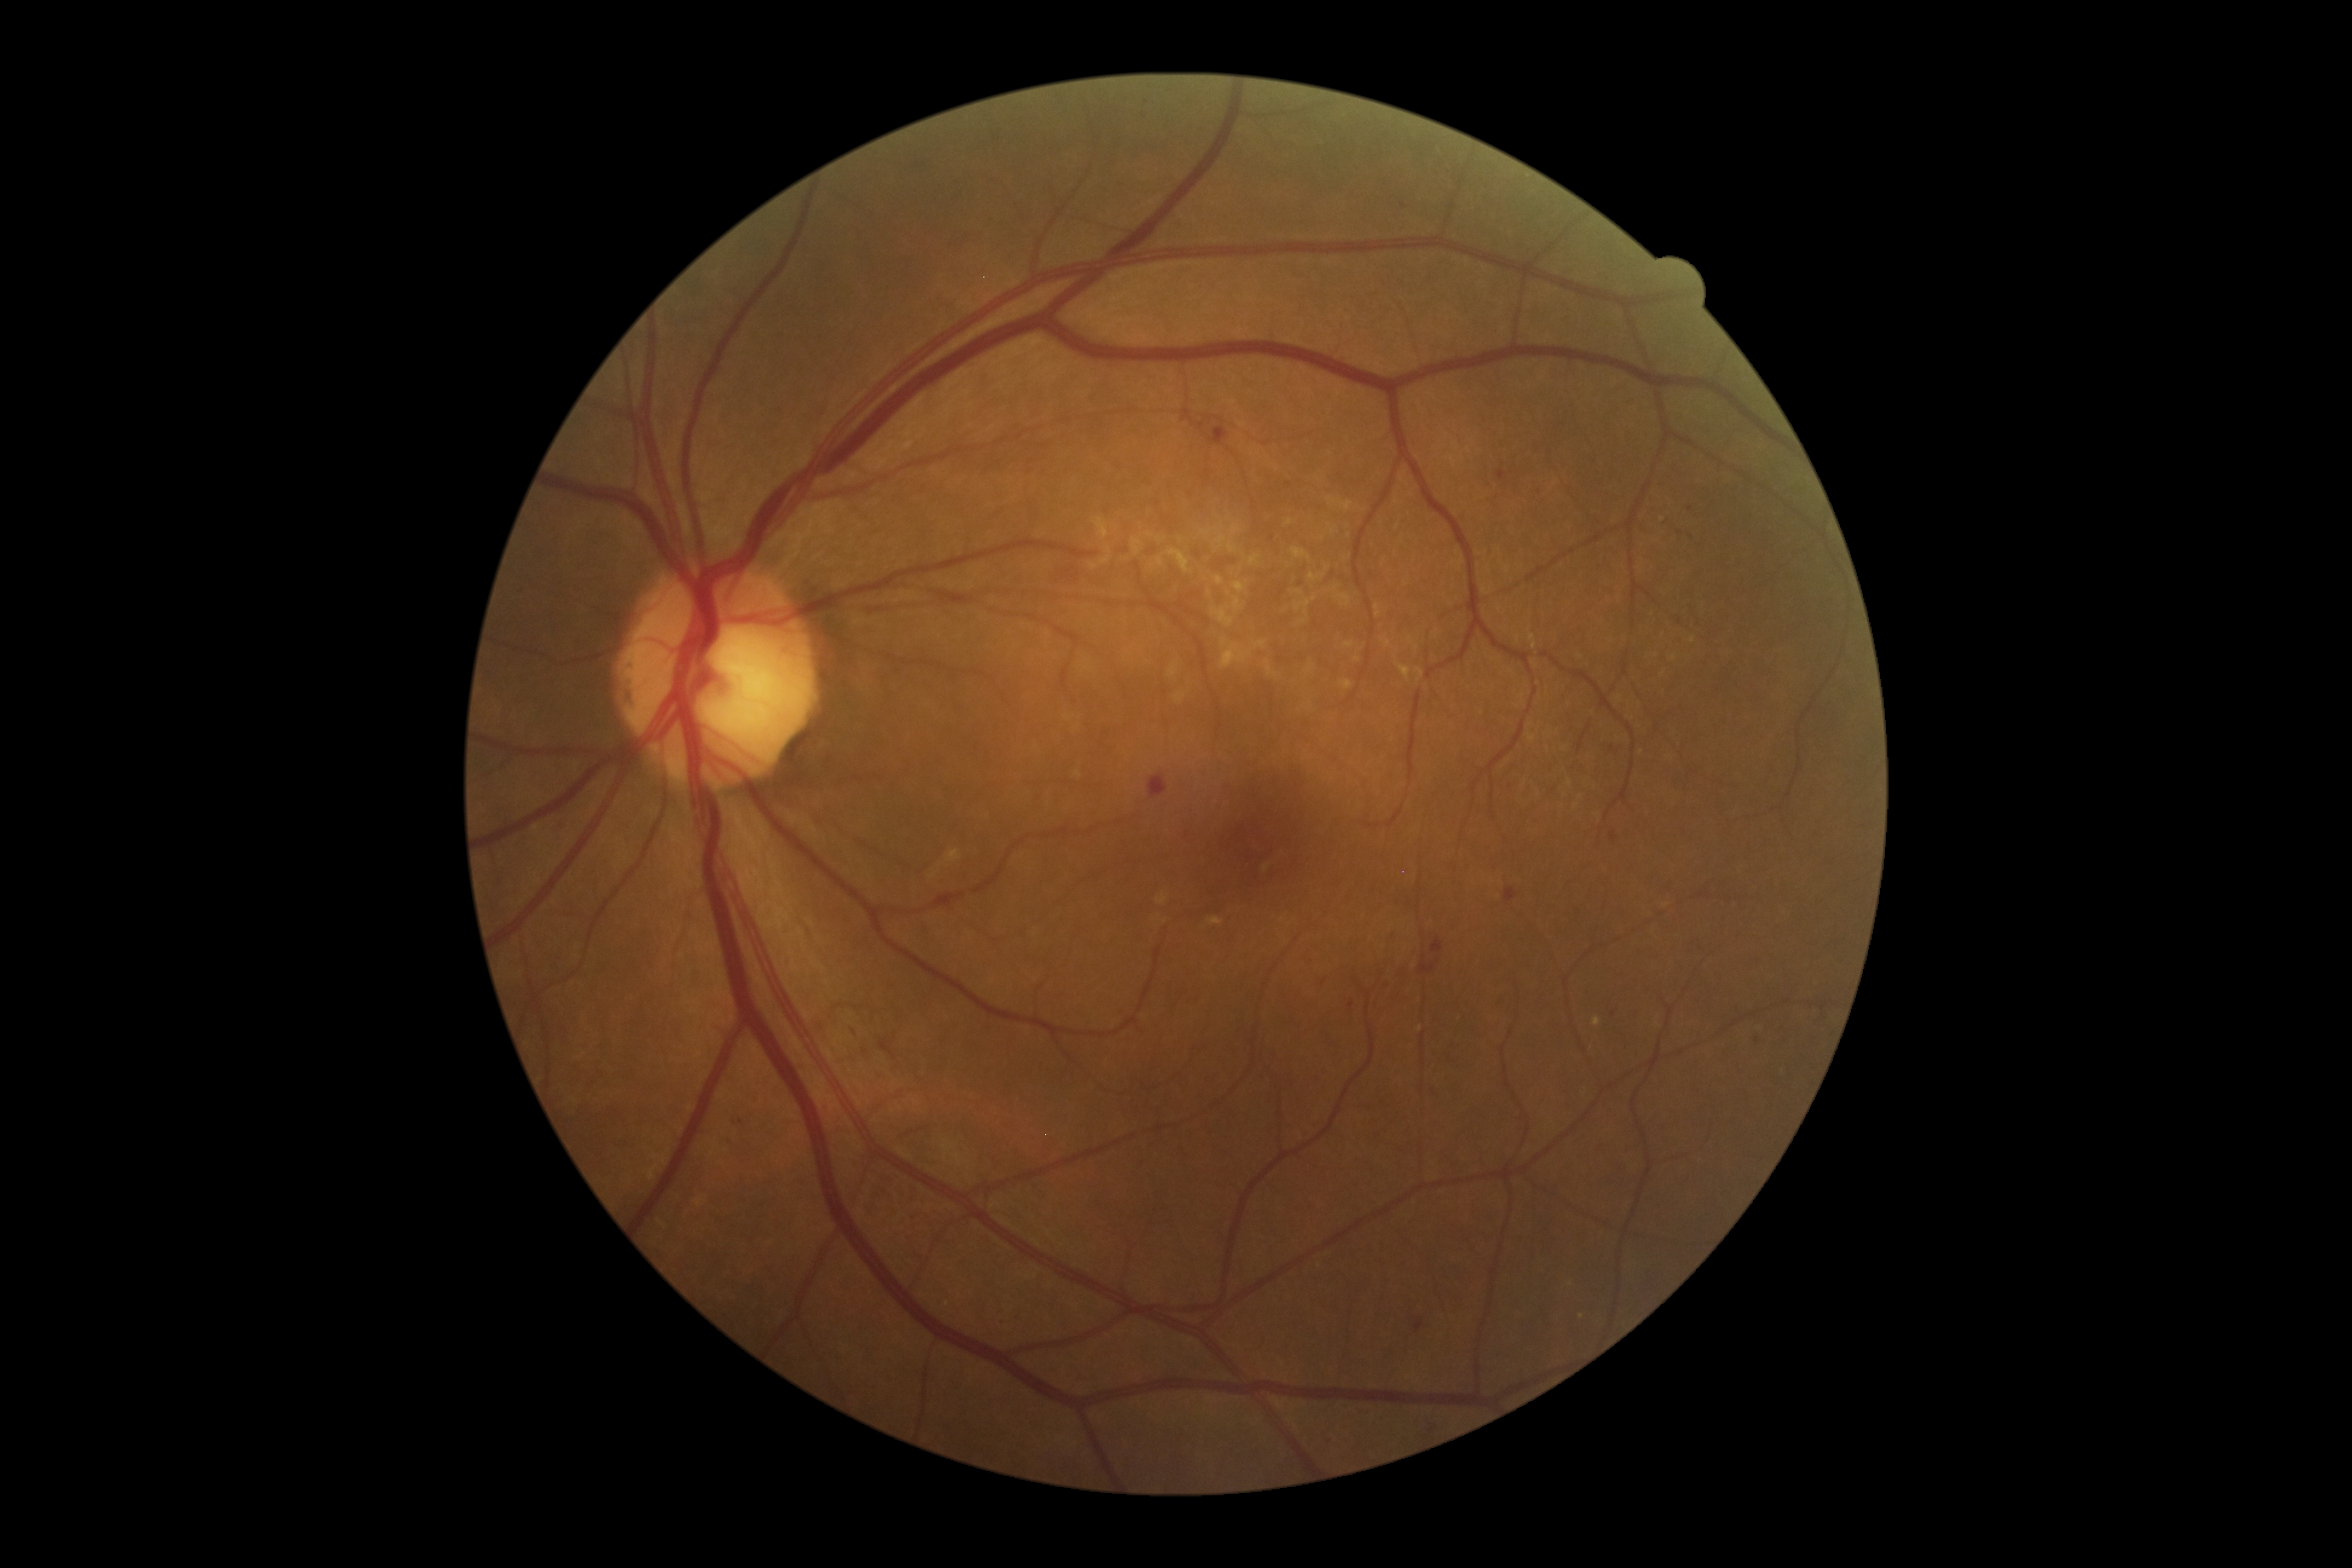
partial: true
dr_grade: 2
lesions:
  ex:
    - bbox=[1593, 1016, 1601, 1027]
  ex_small:
    - [1662, 520]
  ma: []
  se: []
  he:
    - bbox=[1417, 1416, 1443, 1443]
    - bbox=[879, 1039, 897, 1060]
    - bbox=[1611, 832, 1617, 843]
    - bbox=[723, 1135, 734, 1145]
    - bbox=[728, 1111, 743, 1128]
    - bbox=[998, 1307, 1019, 1328]
    - bbox=[916, 918, 931, 933]
    - bbox=[1431, 937, 1443, 953]
    - bbox=[1413, 1317, 1423, 1333]
  he_small:
    - [1614, 1013]
    - [1690, 536]
    - [1351, 1005]